Color fundus image, 45° FOV — 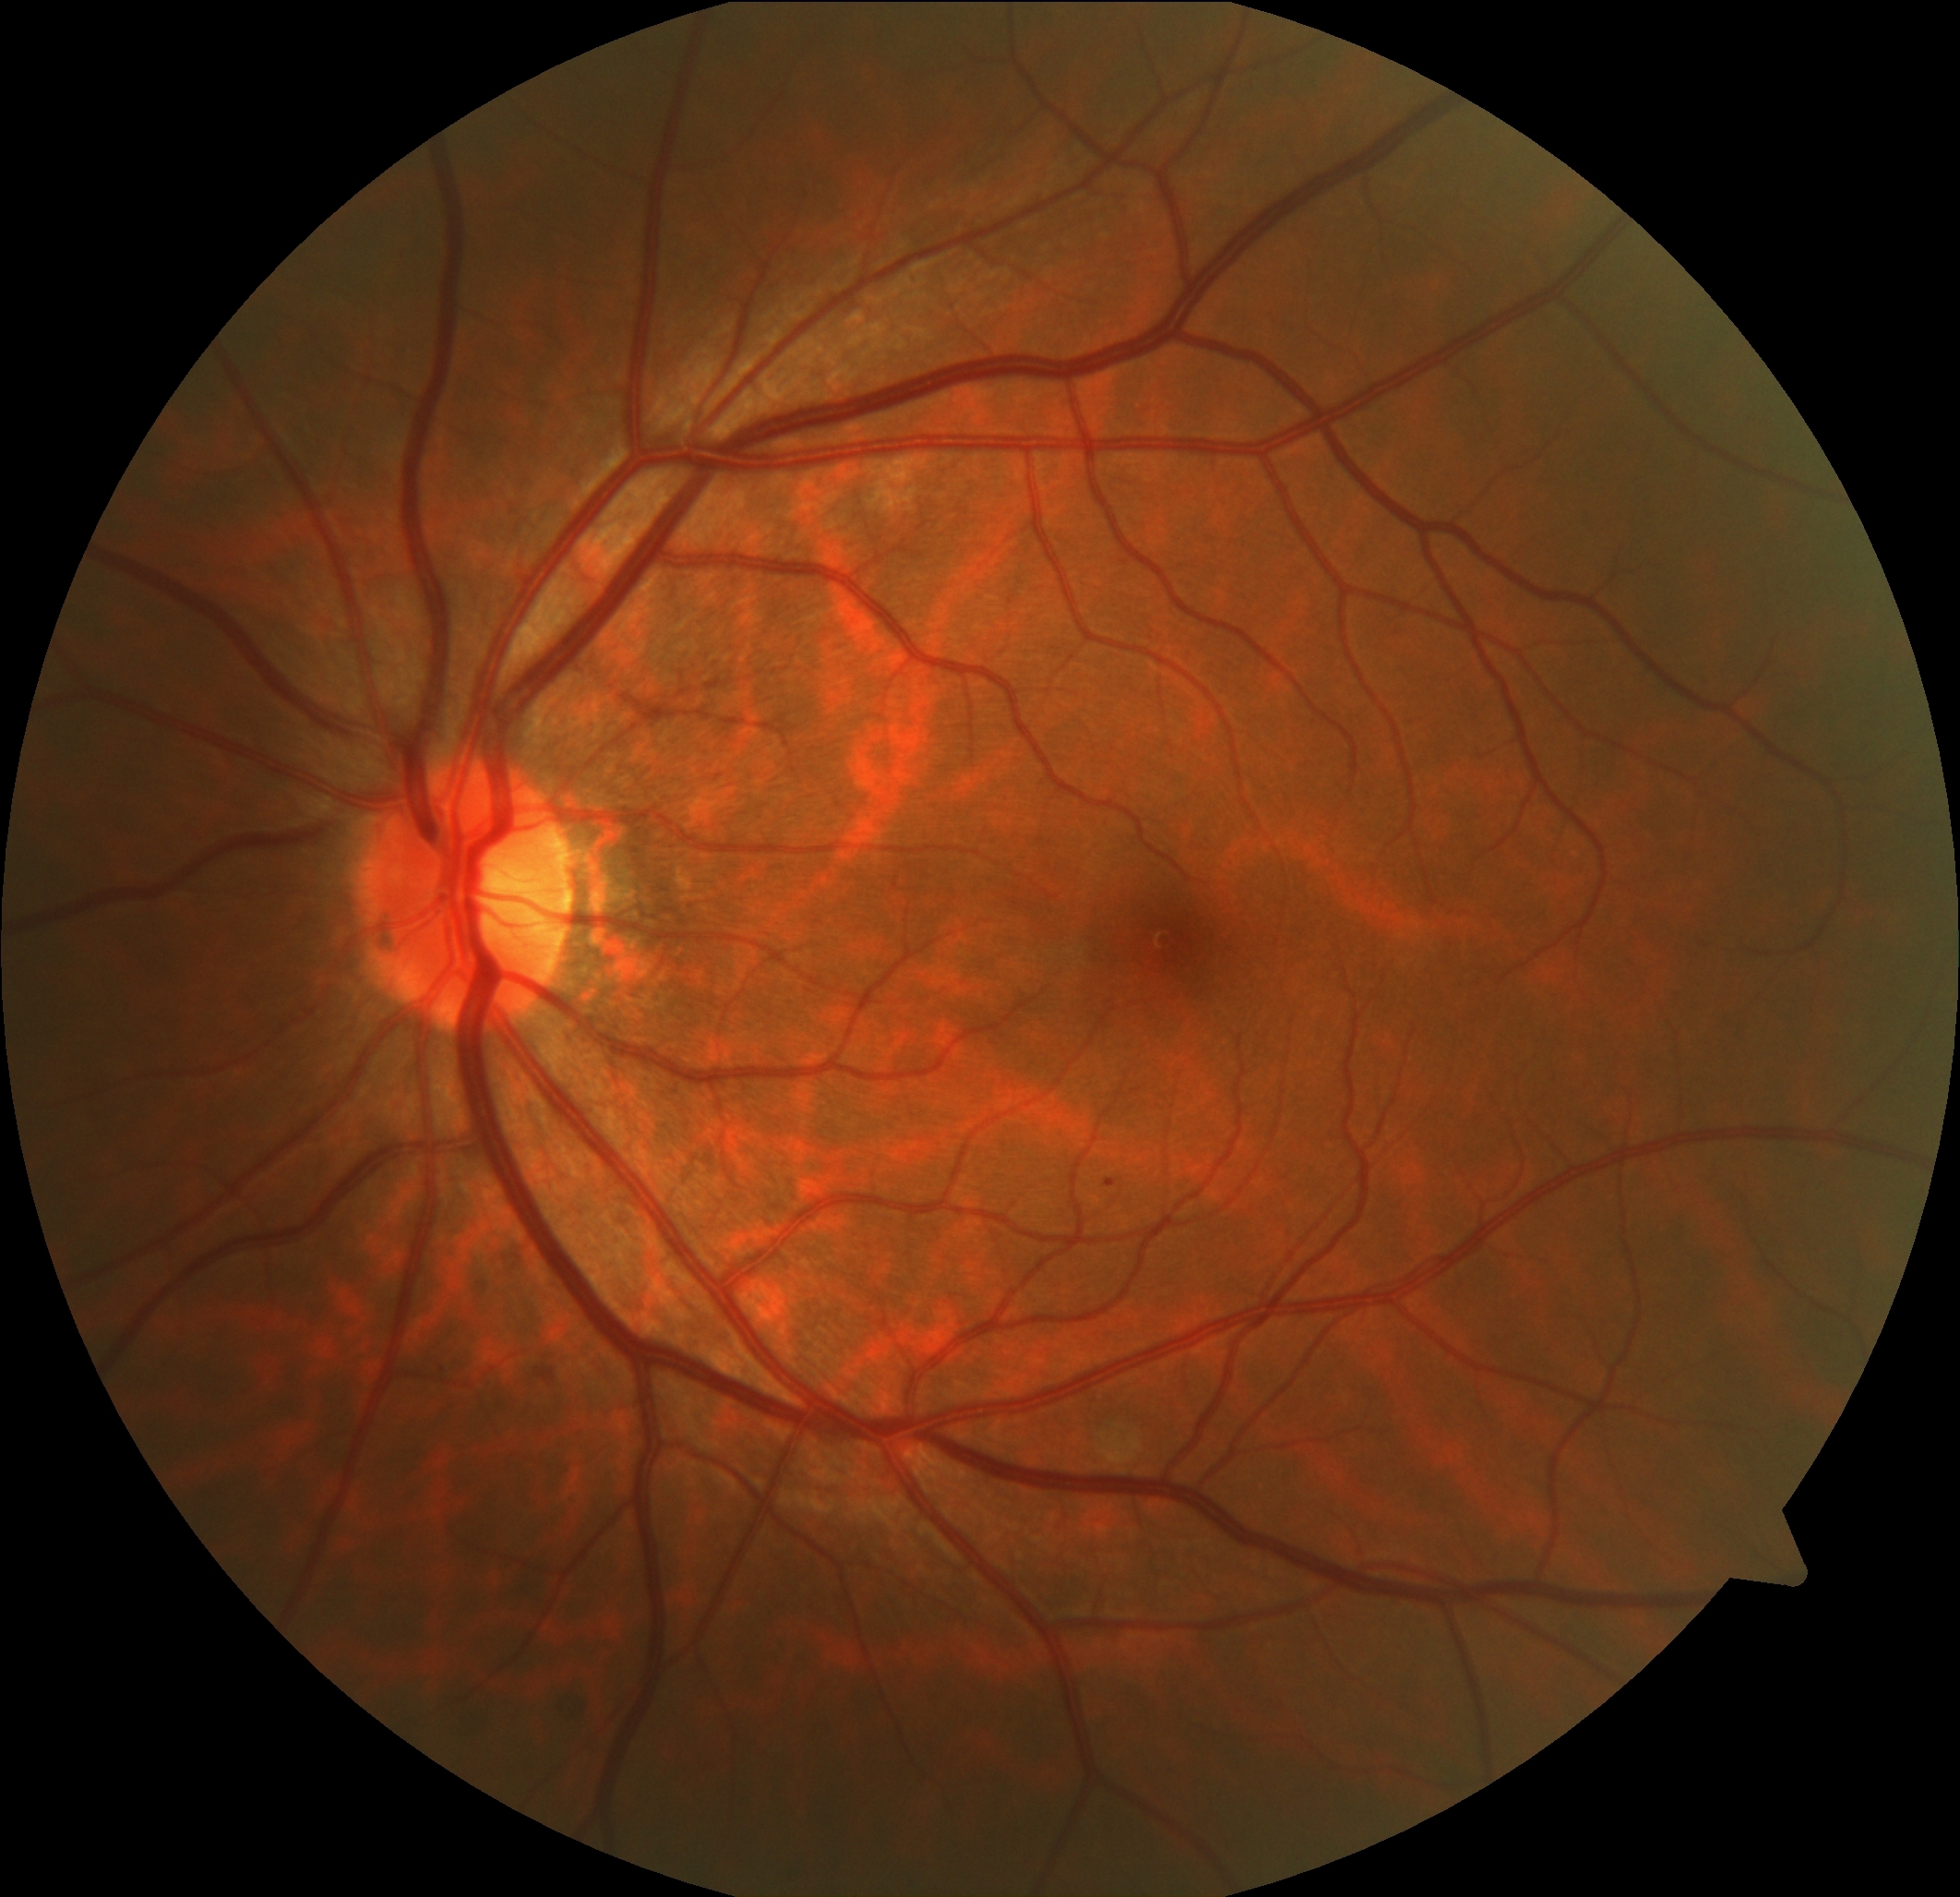

DR grade: 1.
The retinopathy is classified as non-proliferative diabetic retinopathy.